Wide-field fundus image from infant ROP screening. Clarity RetCam 3, 130° FOV. Image size 640x480.
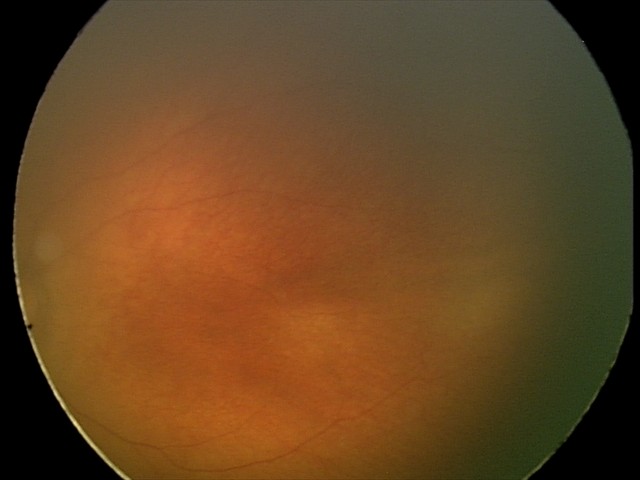

Screening examination diagnosed as physiological.